Modified Davis classification, nonmydriatic fundus photograph, posterior pole color fundus photograph.
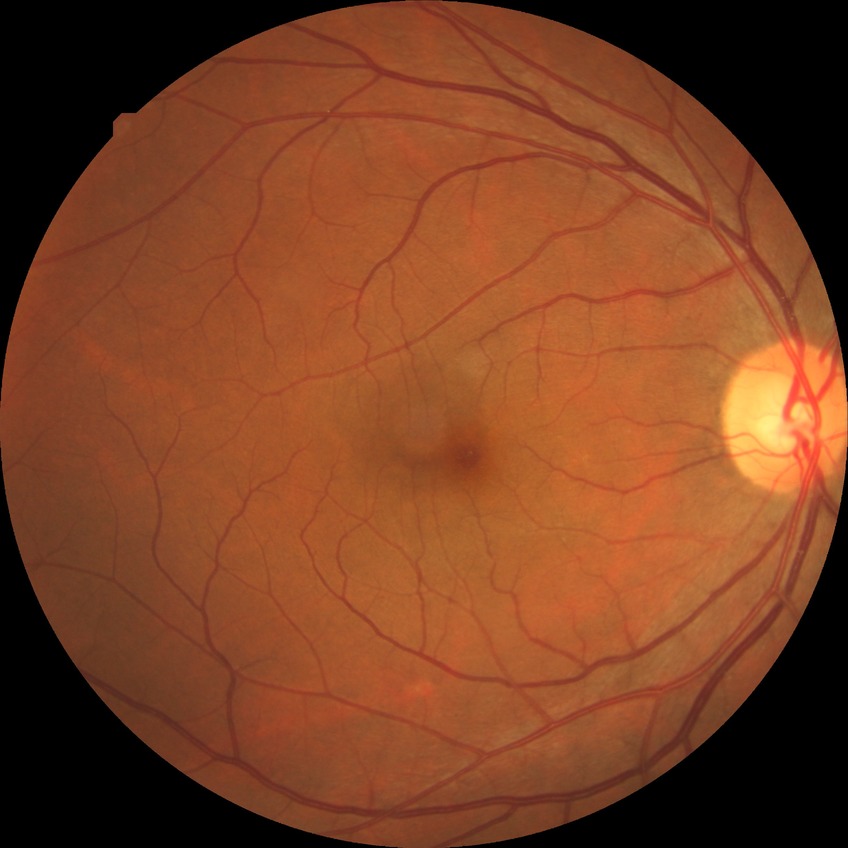
Diabetic retinopathy (DR) is NDR (no diabetic retinopathy).